Posterior pole color fundus photograph: 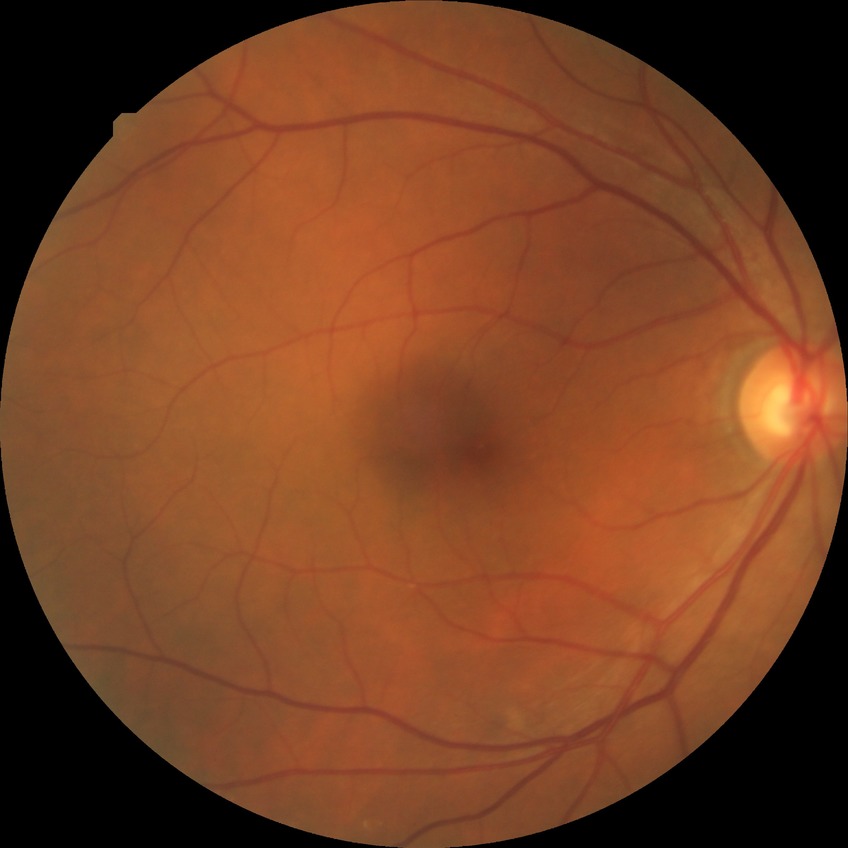
Diabetic retinopathy severity is simple diabetic retinopathy.